50° field of view.
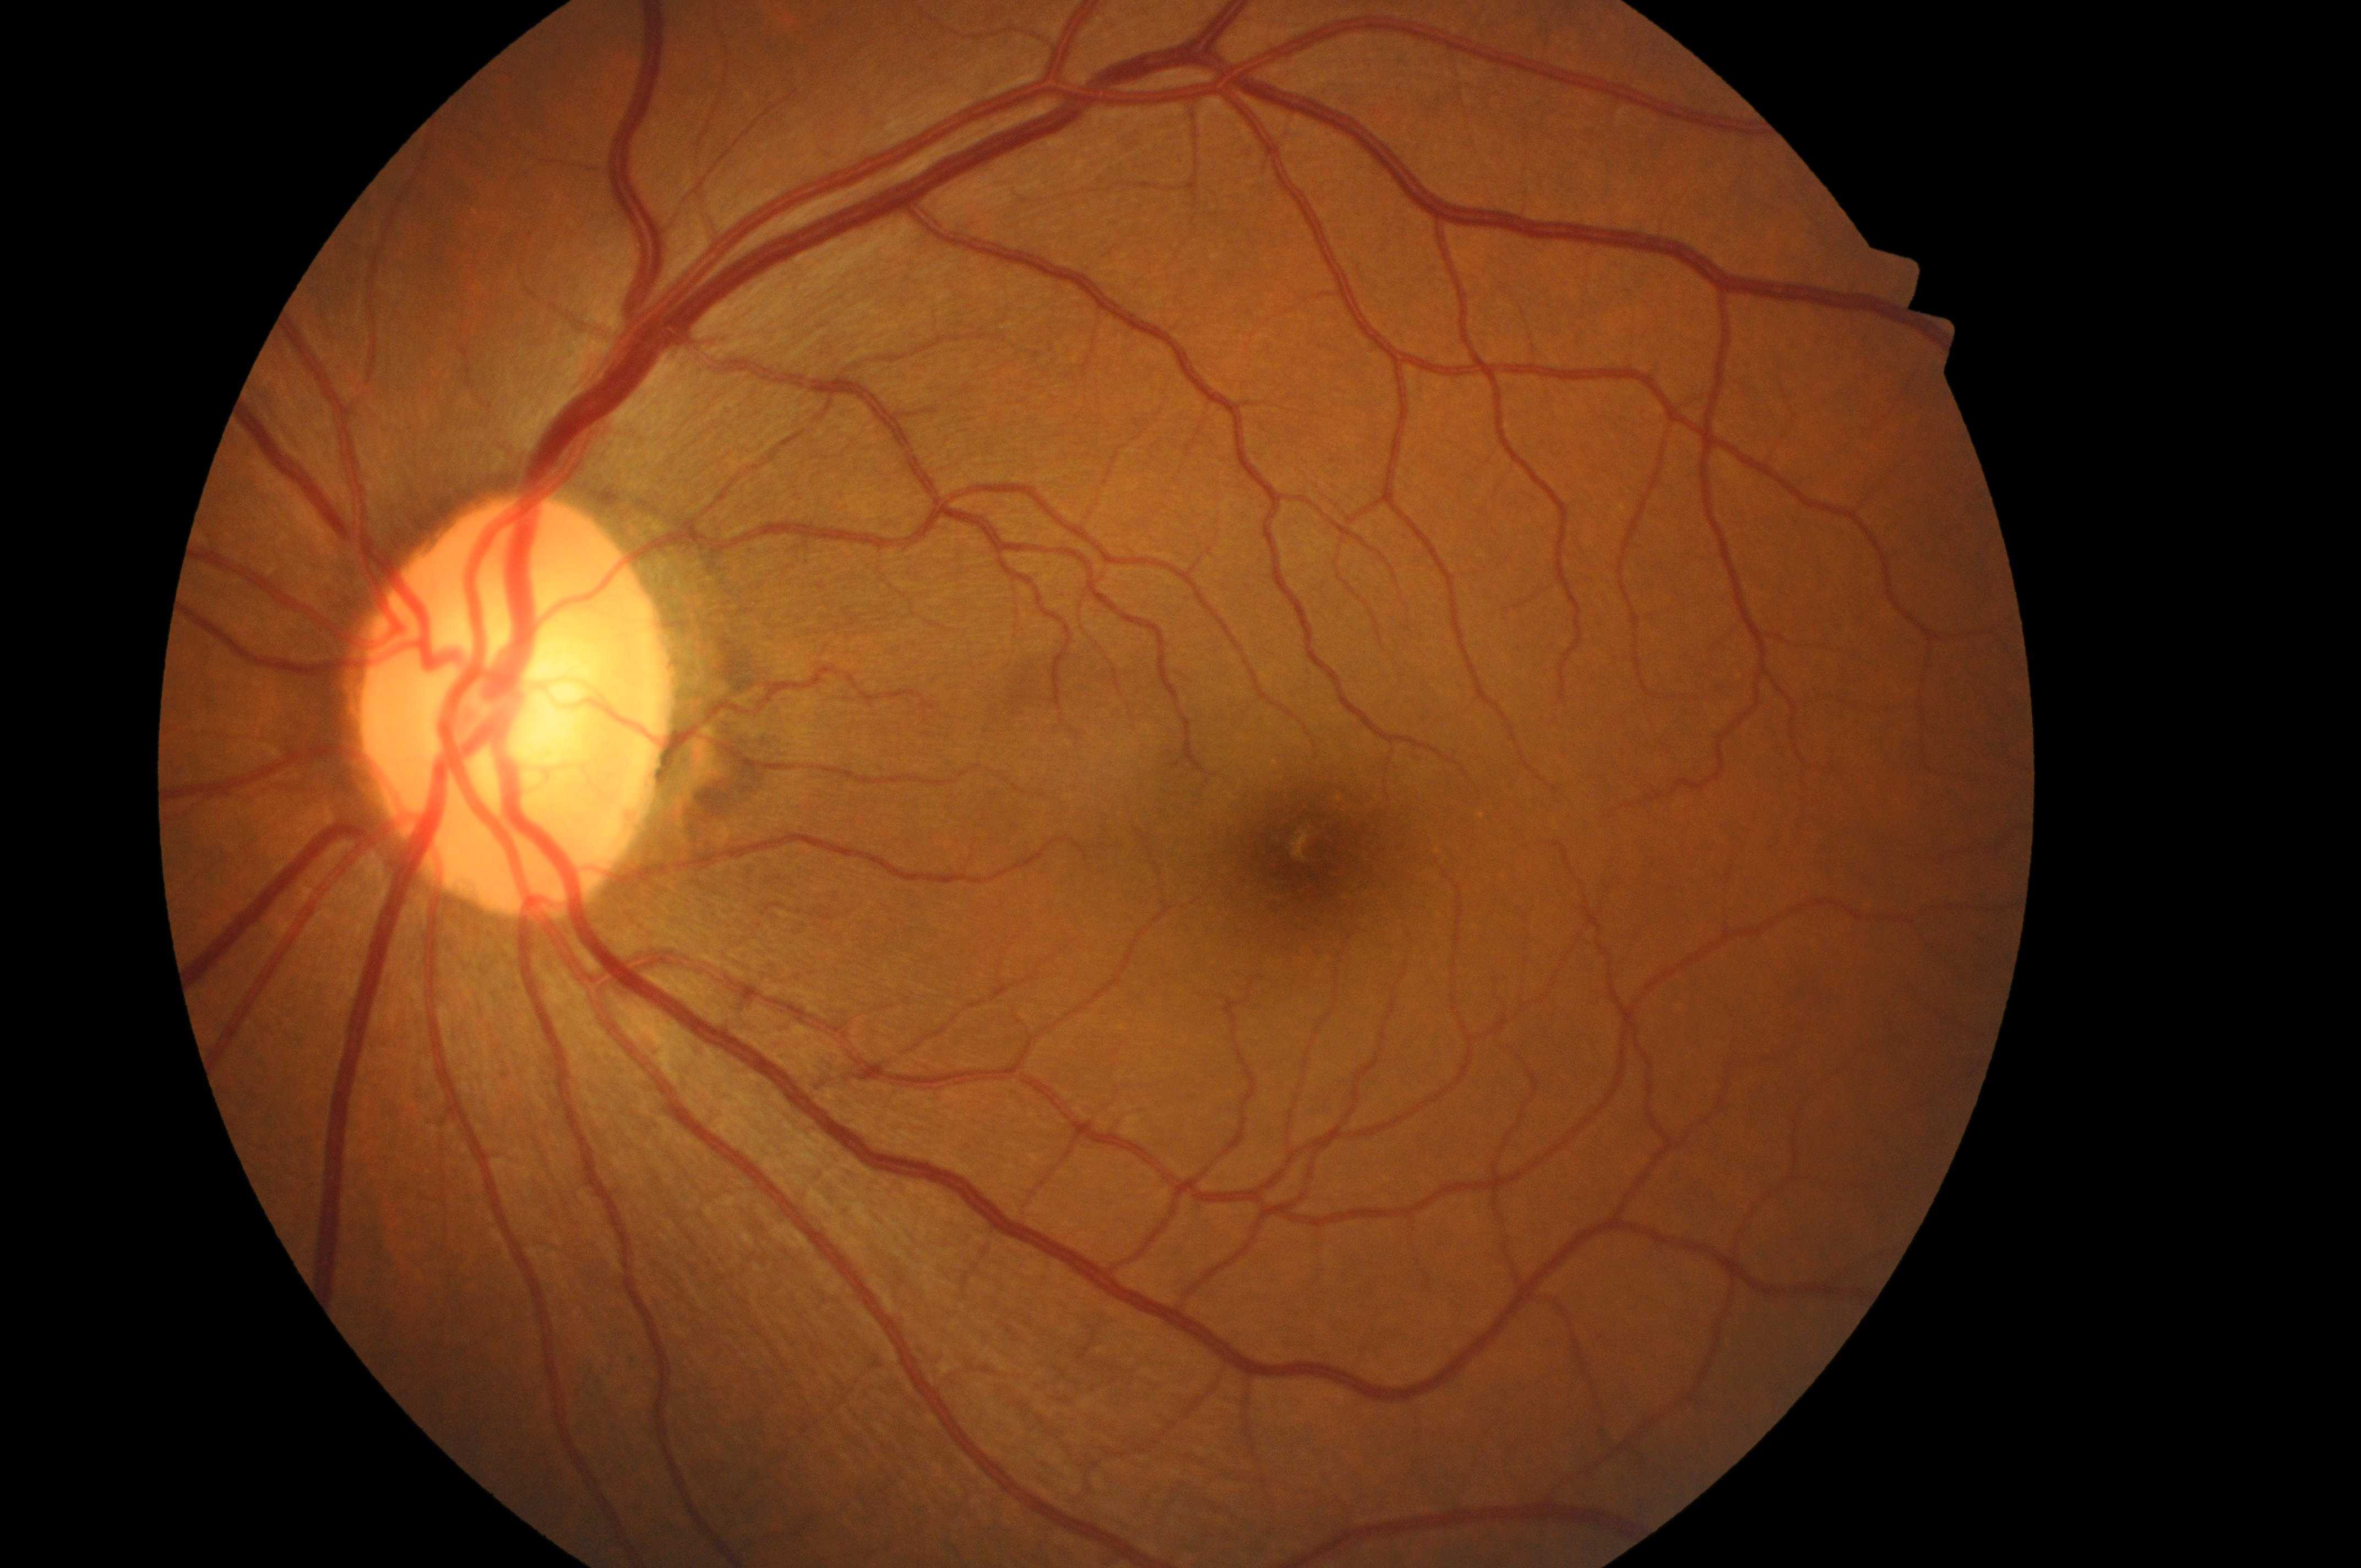
Annotations:
• laterality · the left eye
• diabetic retinopathy (DR) · 0/4
• diabetic macular edema (DME) · grade 0
• the fovea · 1318, 856
• DR impression · No diabetic retinopathy; no macular edema risk
• optic disc · 507, 721